Wide-field retinal mosaic image · 1924 by 1556 pixels · FOV: 200 degrees
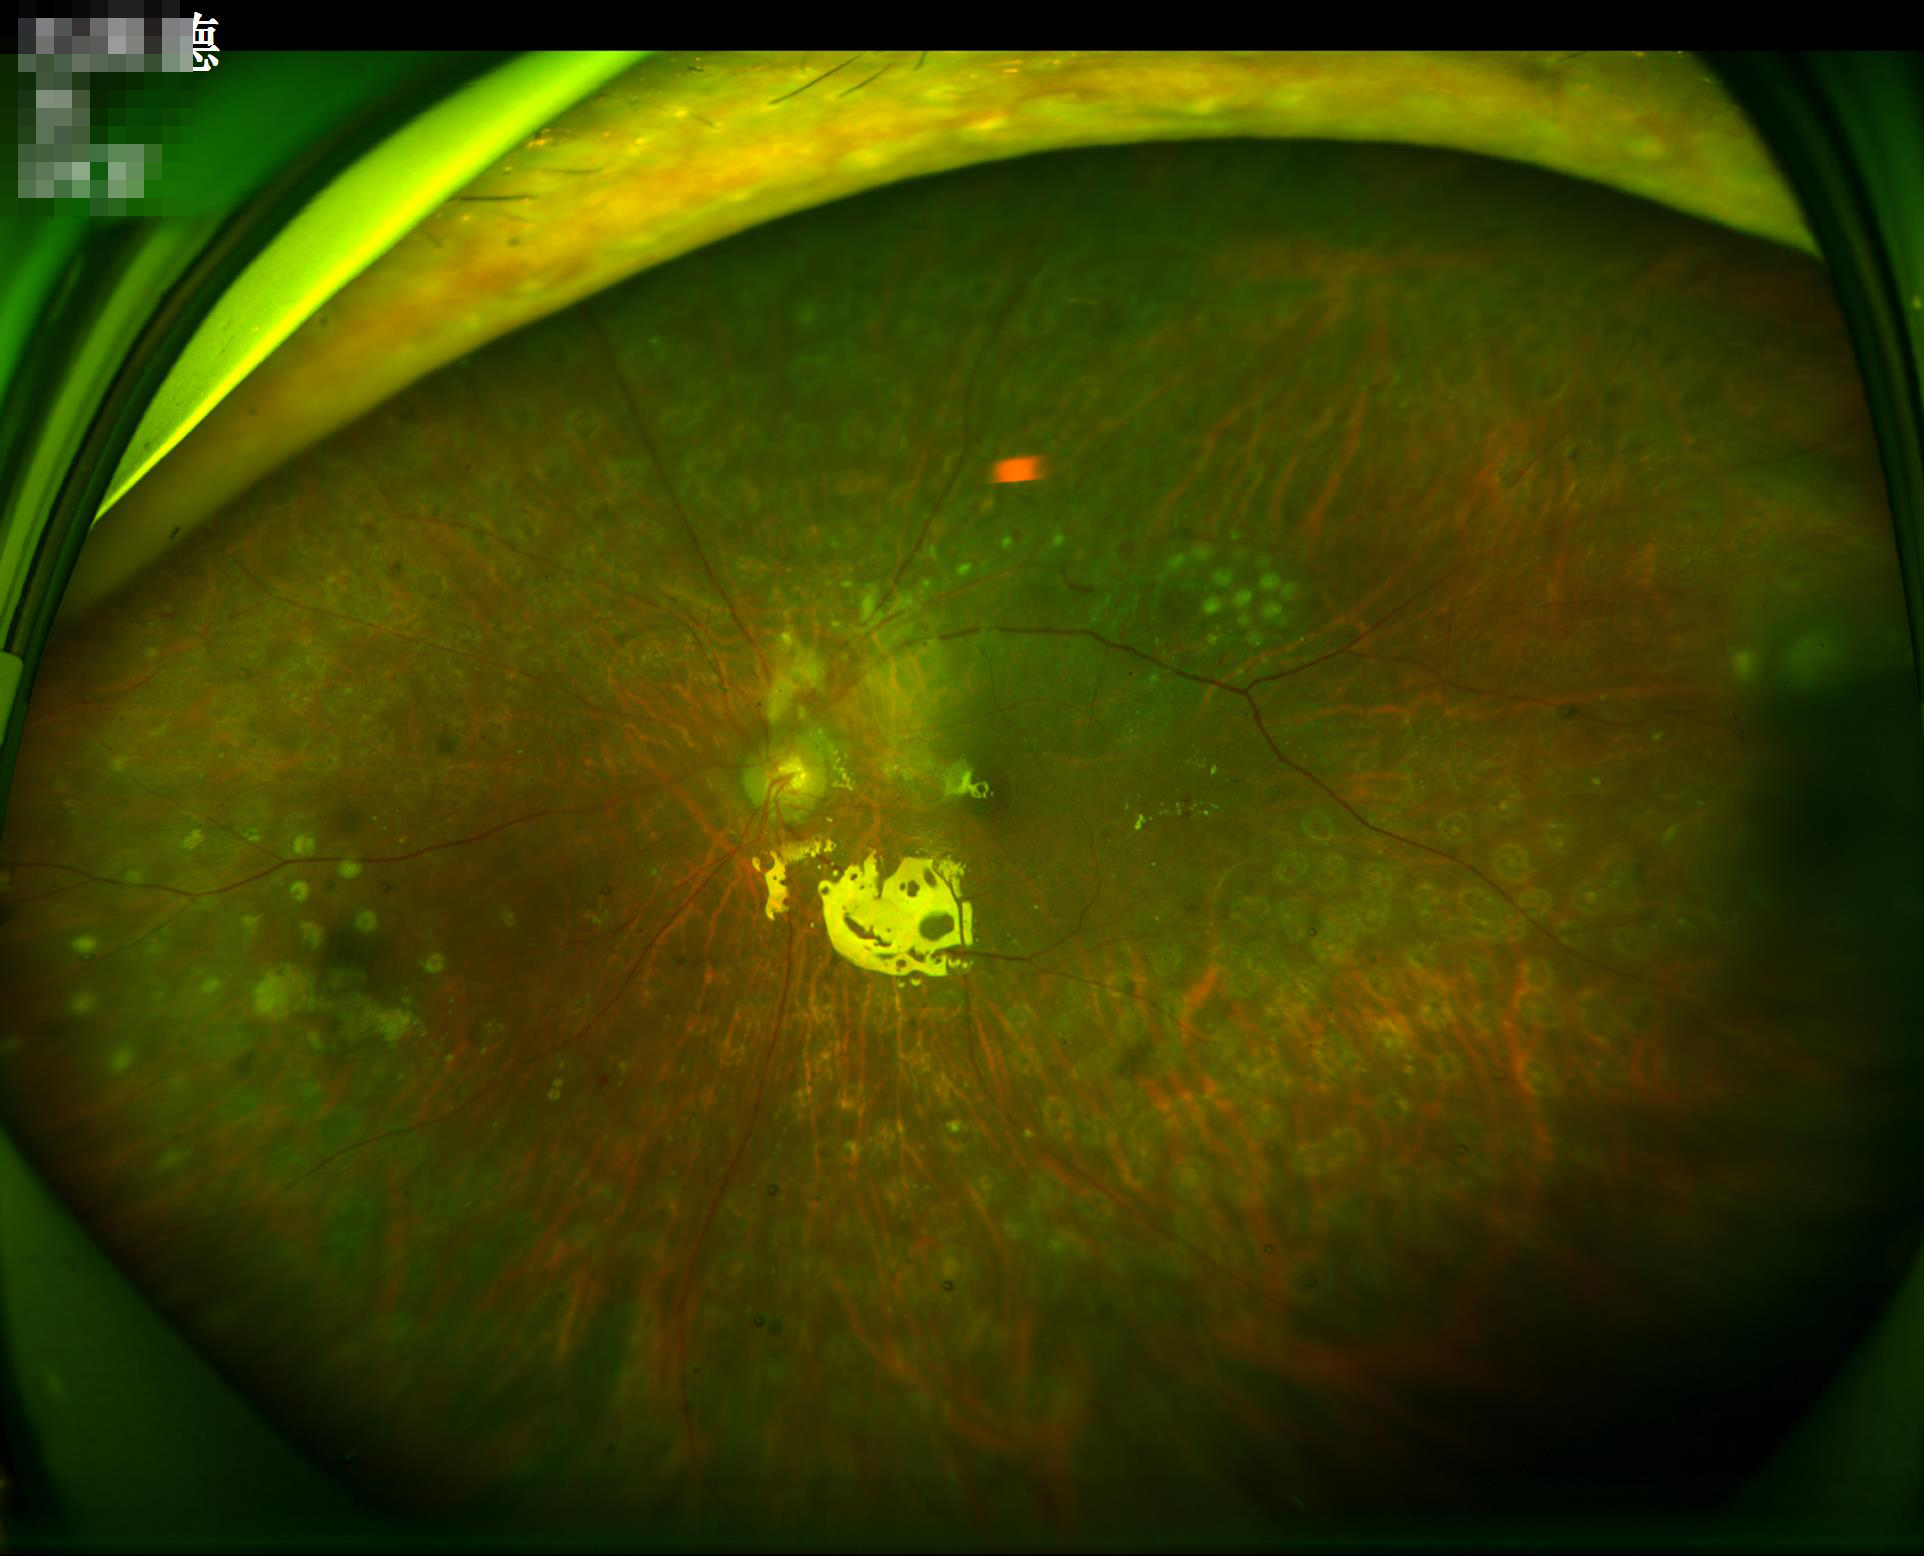 Illumination and color are suboptimal. Optic disc, vessels, and background are in focus. Adequate contrast for distinguishing structures. Overall image quality is good.